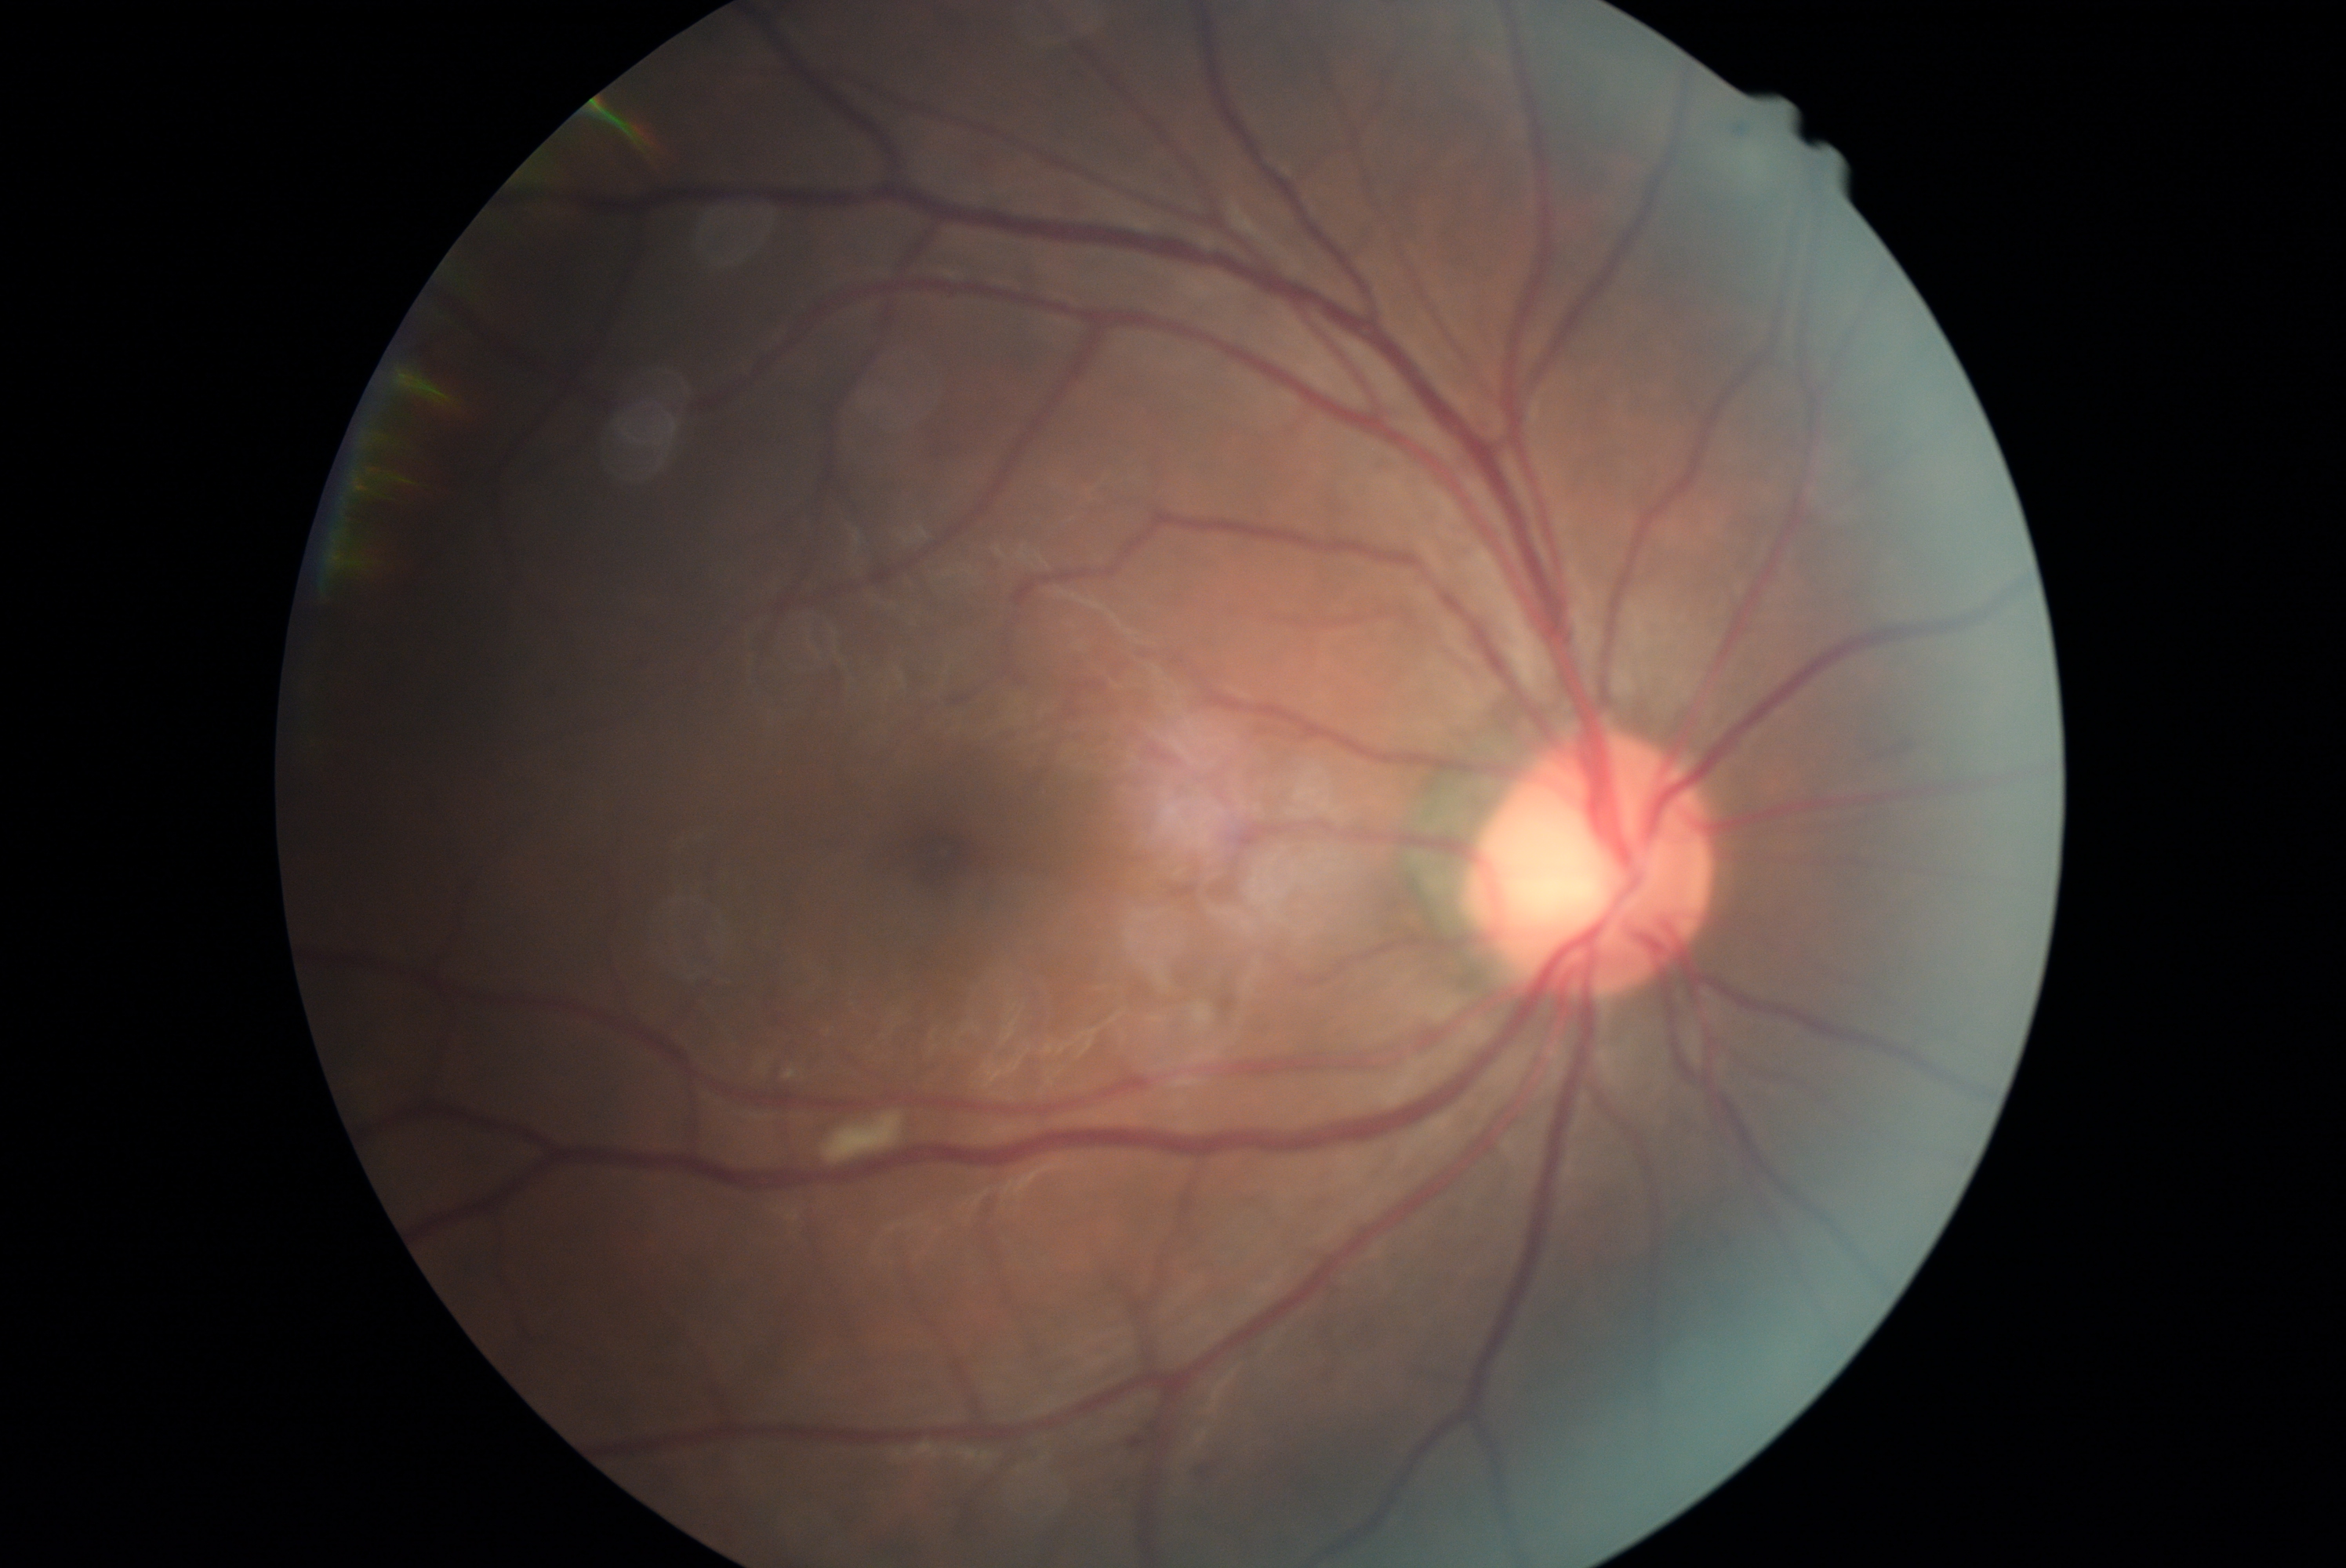
retinopathy grade=moderate NPDR (2).